848x848px · acquired with a NIDEK AFC-230 · color fundus photograph · 45 degree fundus photograph — 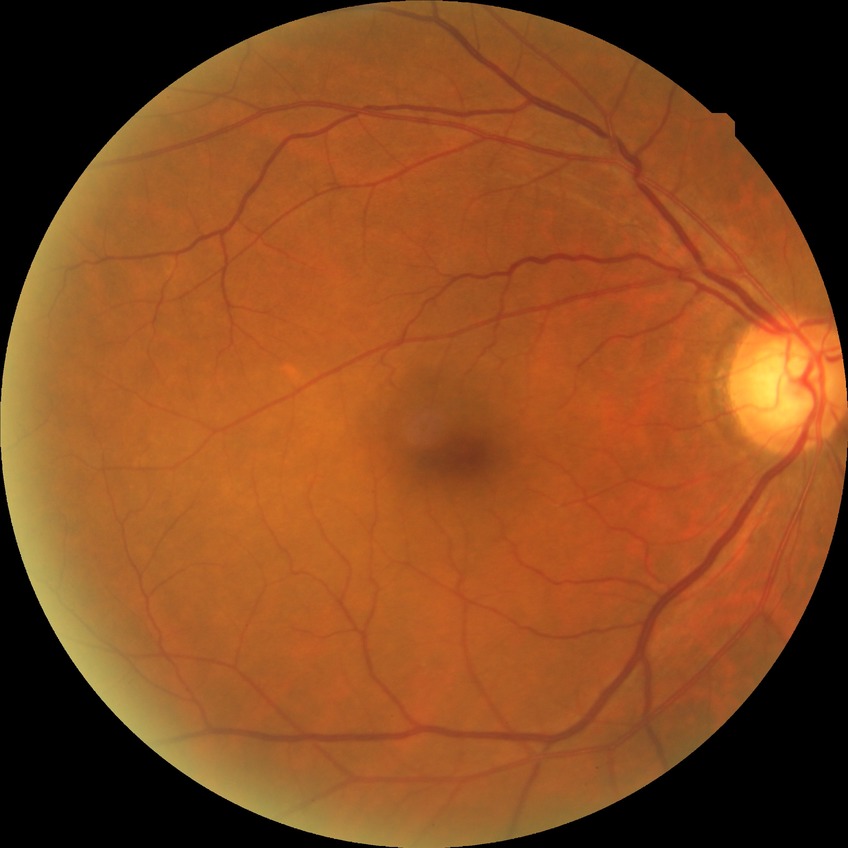

DR stage is NDR.